45° field of view; 2048 by 1536 pixels.
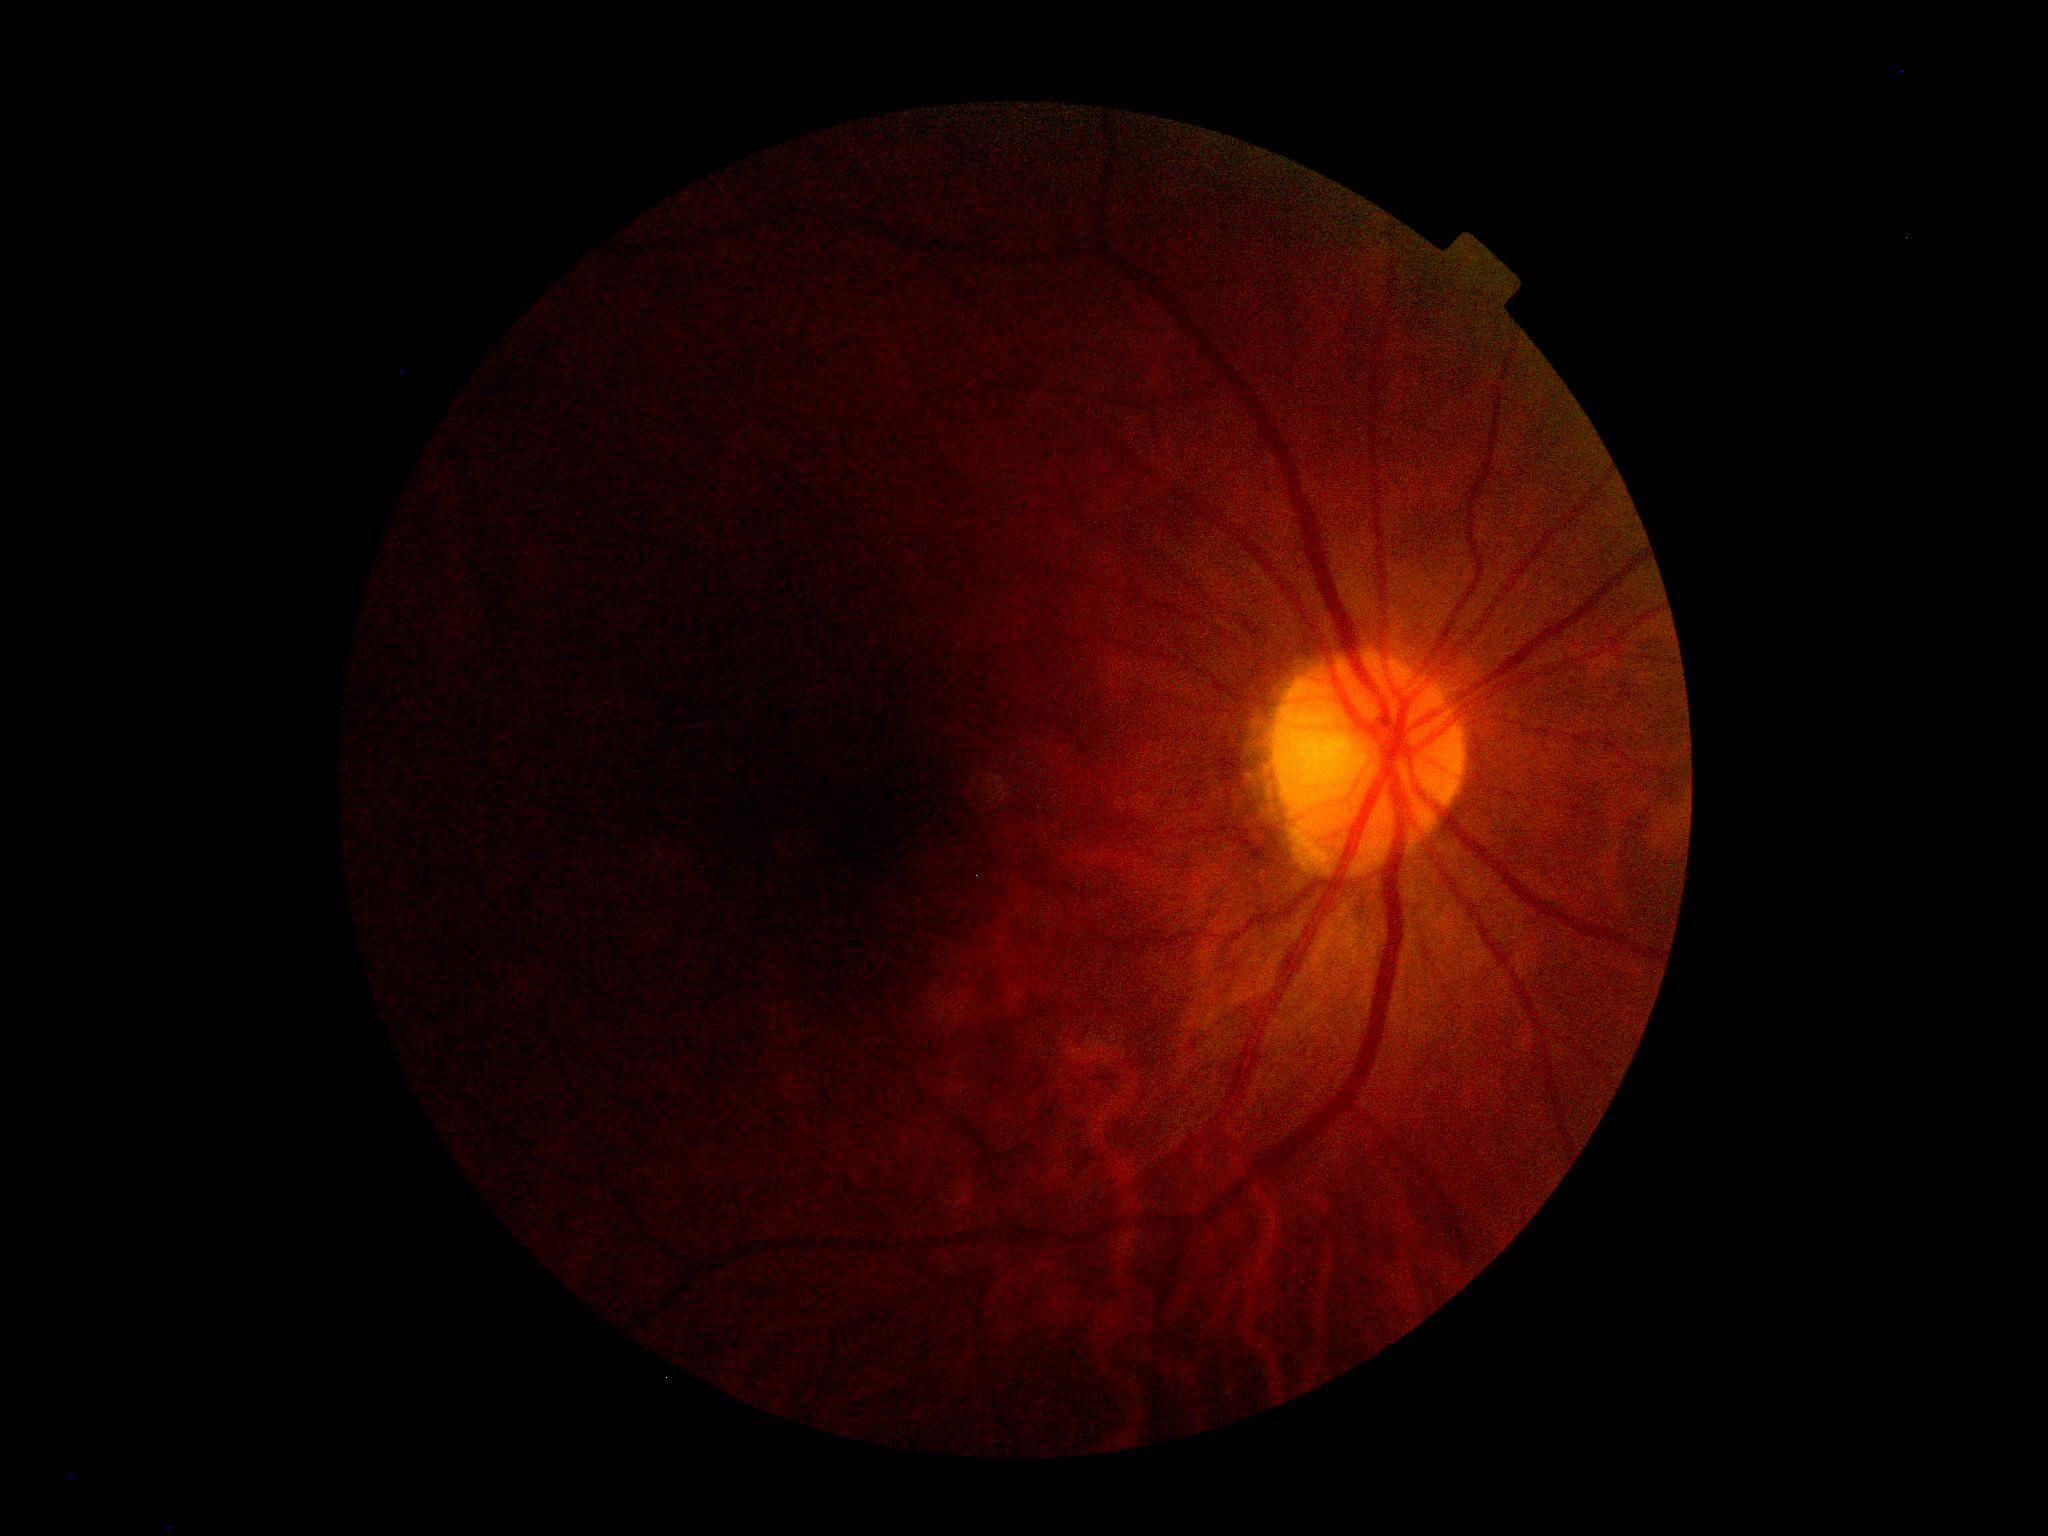 diabetic retinopathy grade = ungradable due to poor image quality; image quality = insufficient.